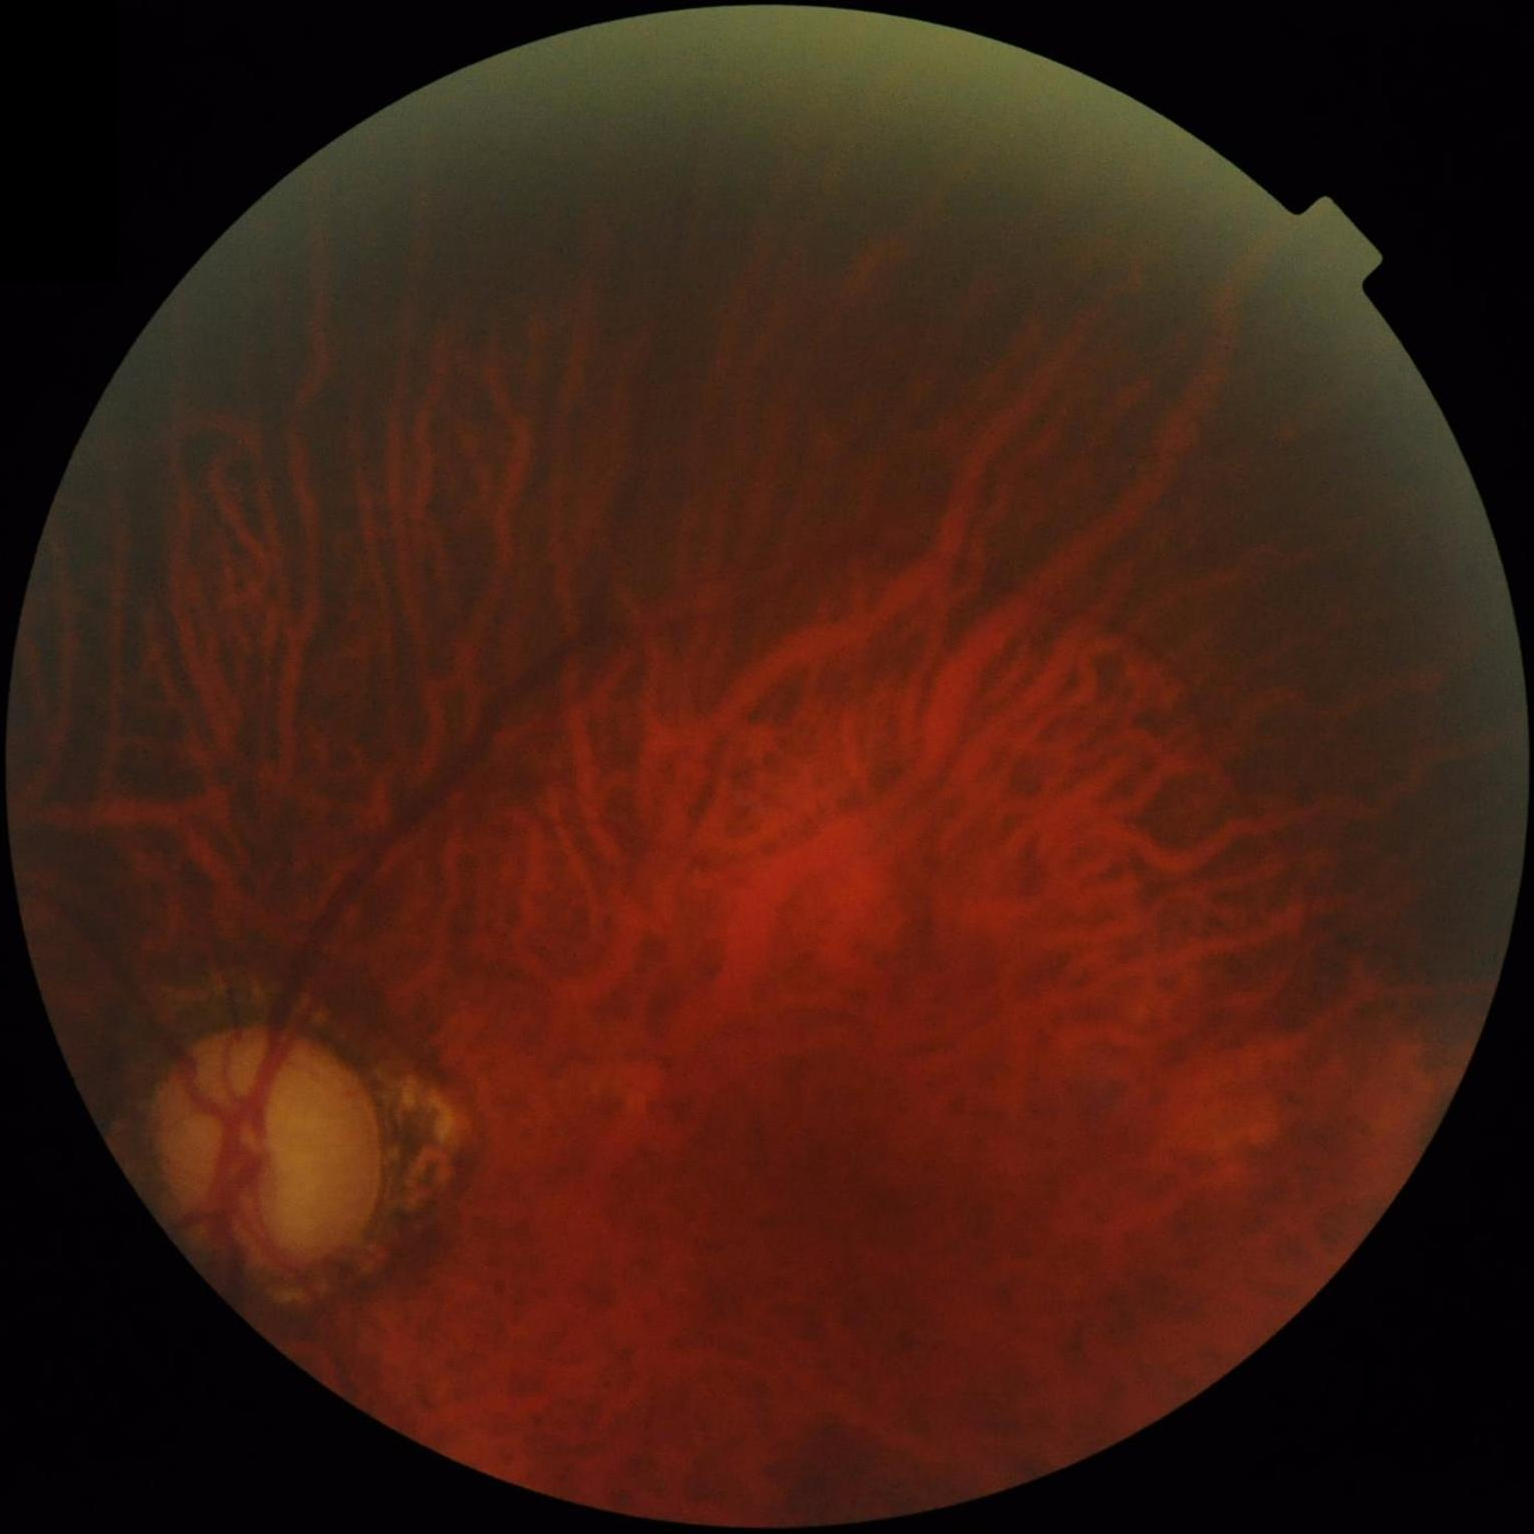

Image quality assessment:
- contrast: poor
- focus: out of focus
- overall: suboptimal
- illumination: suboptimal